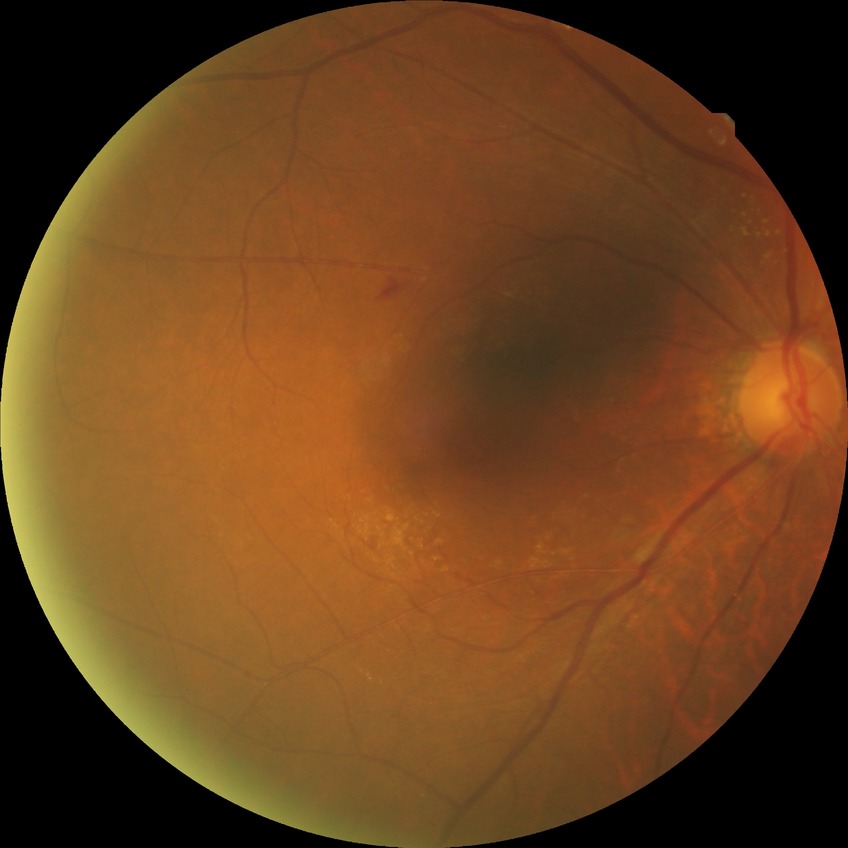
DR stage is SDR.